848x848; 45 degree fundus photograph:
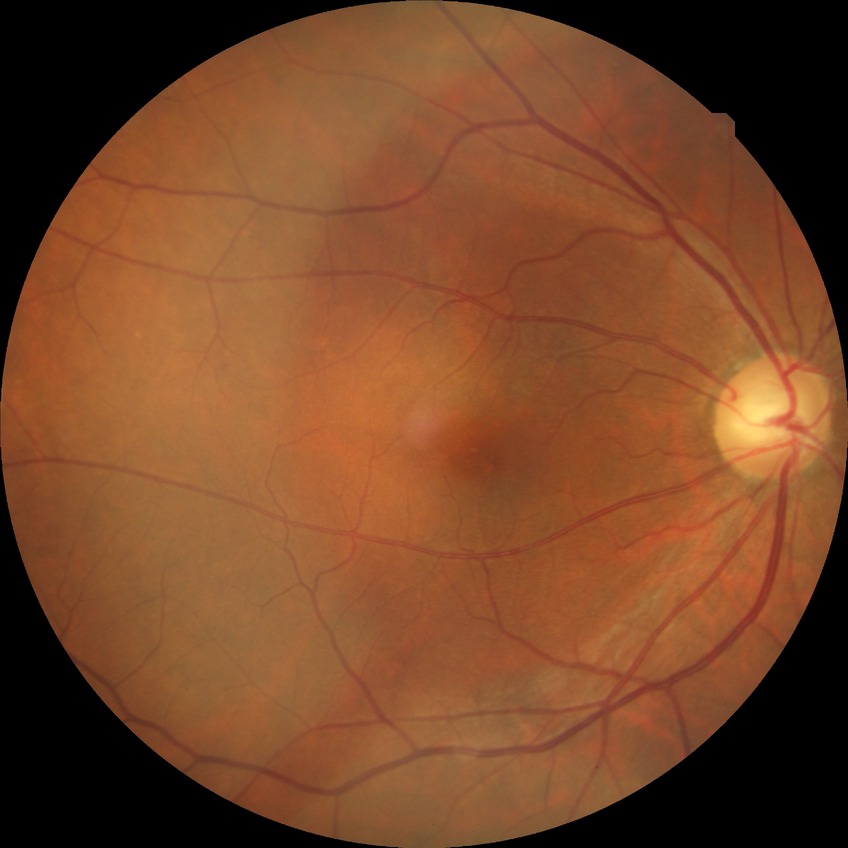 Diabetic retinopathy grade: no diabetic retinopathy.